Modified Davis grading:
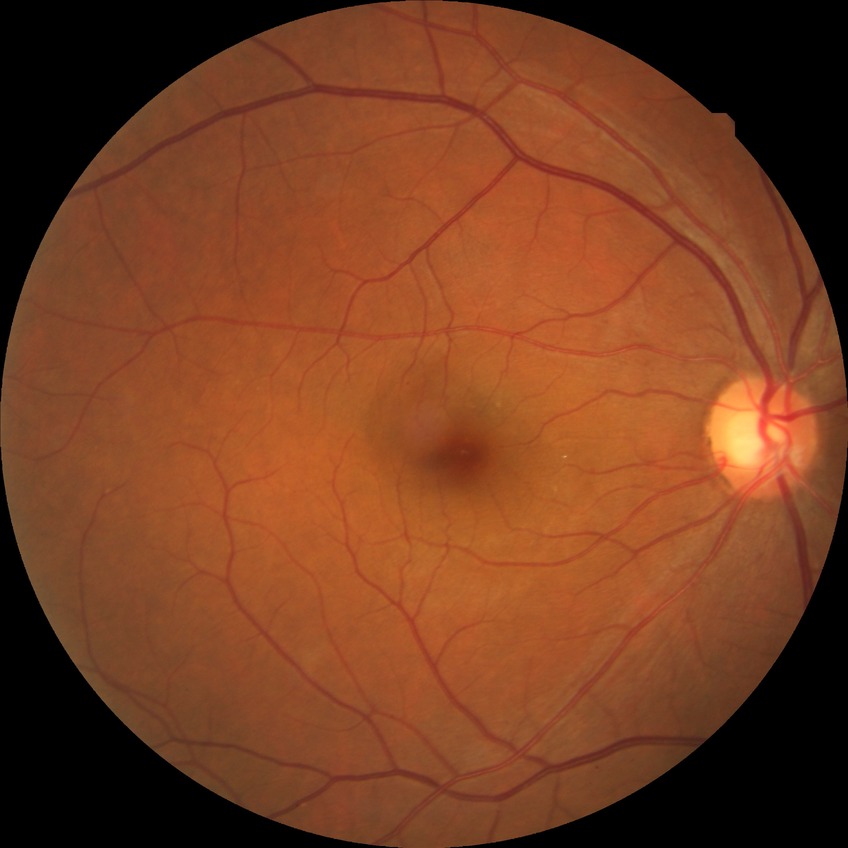
Diabetic retinopathy (DR): SDR (simple diabetic retinopathy).